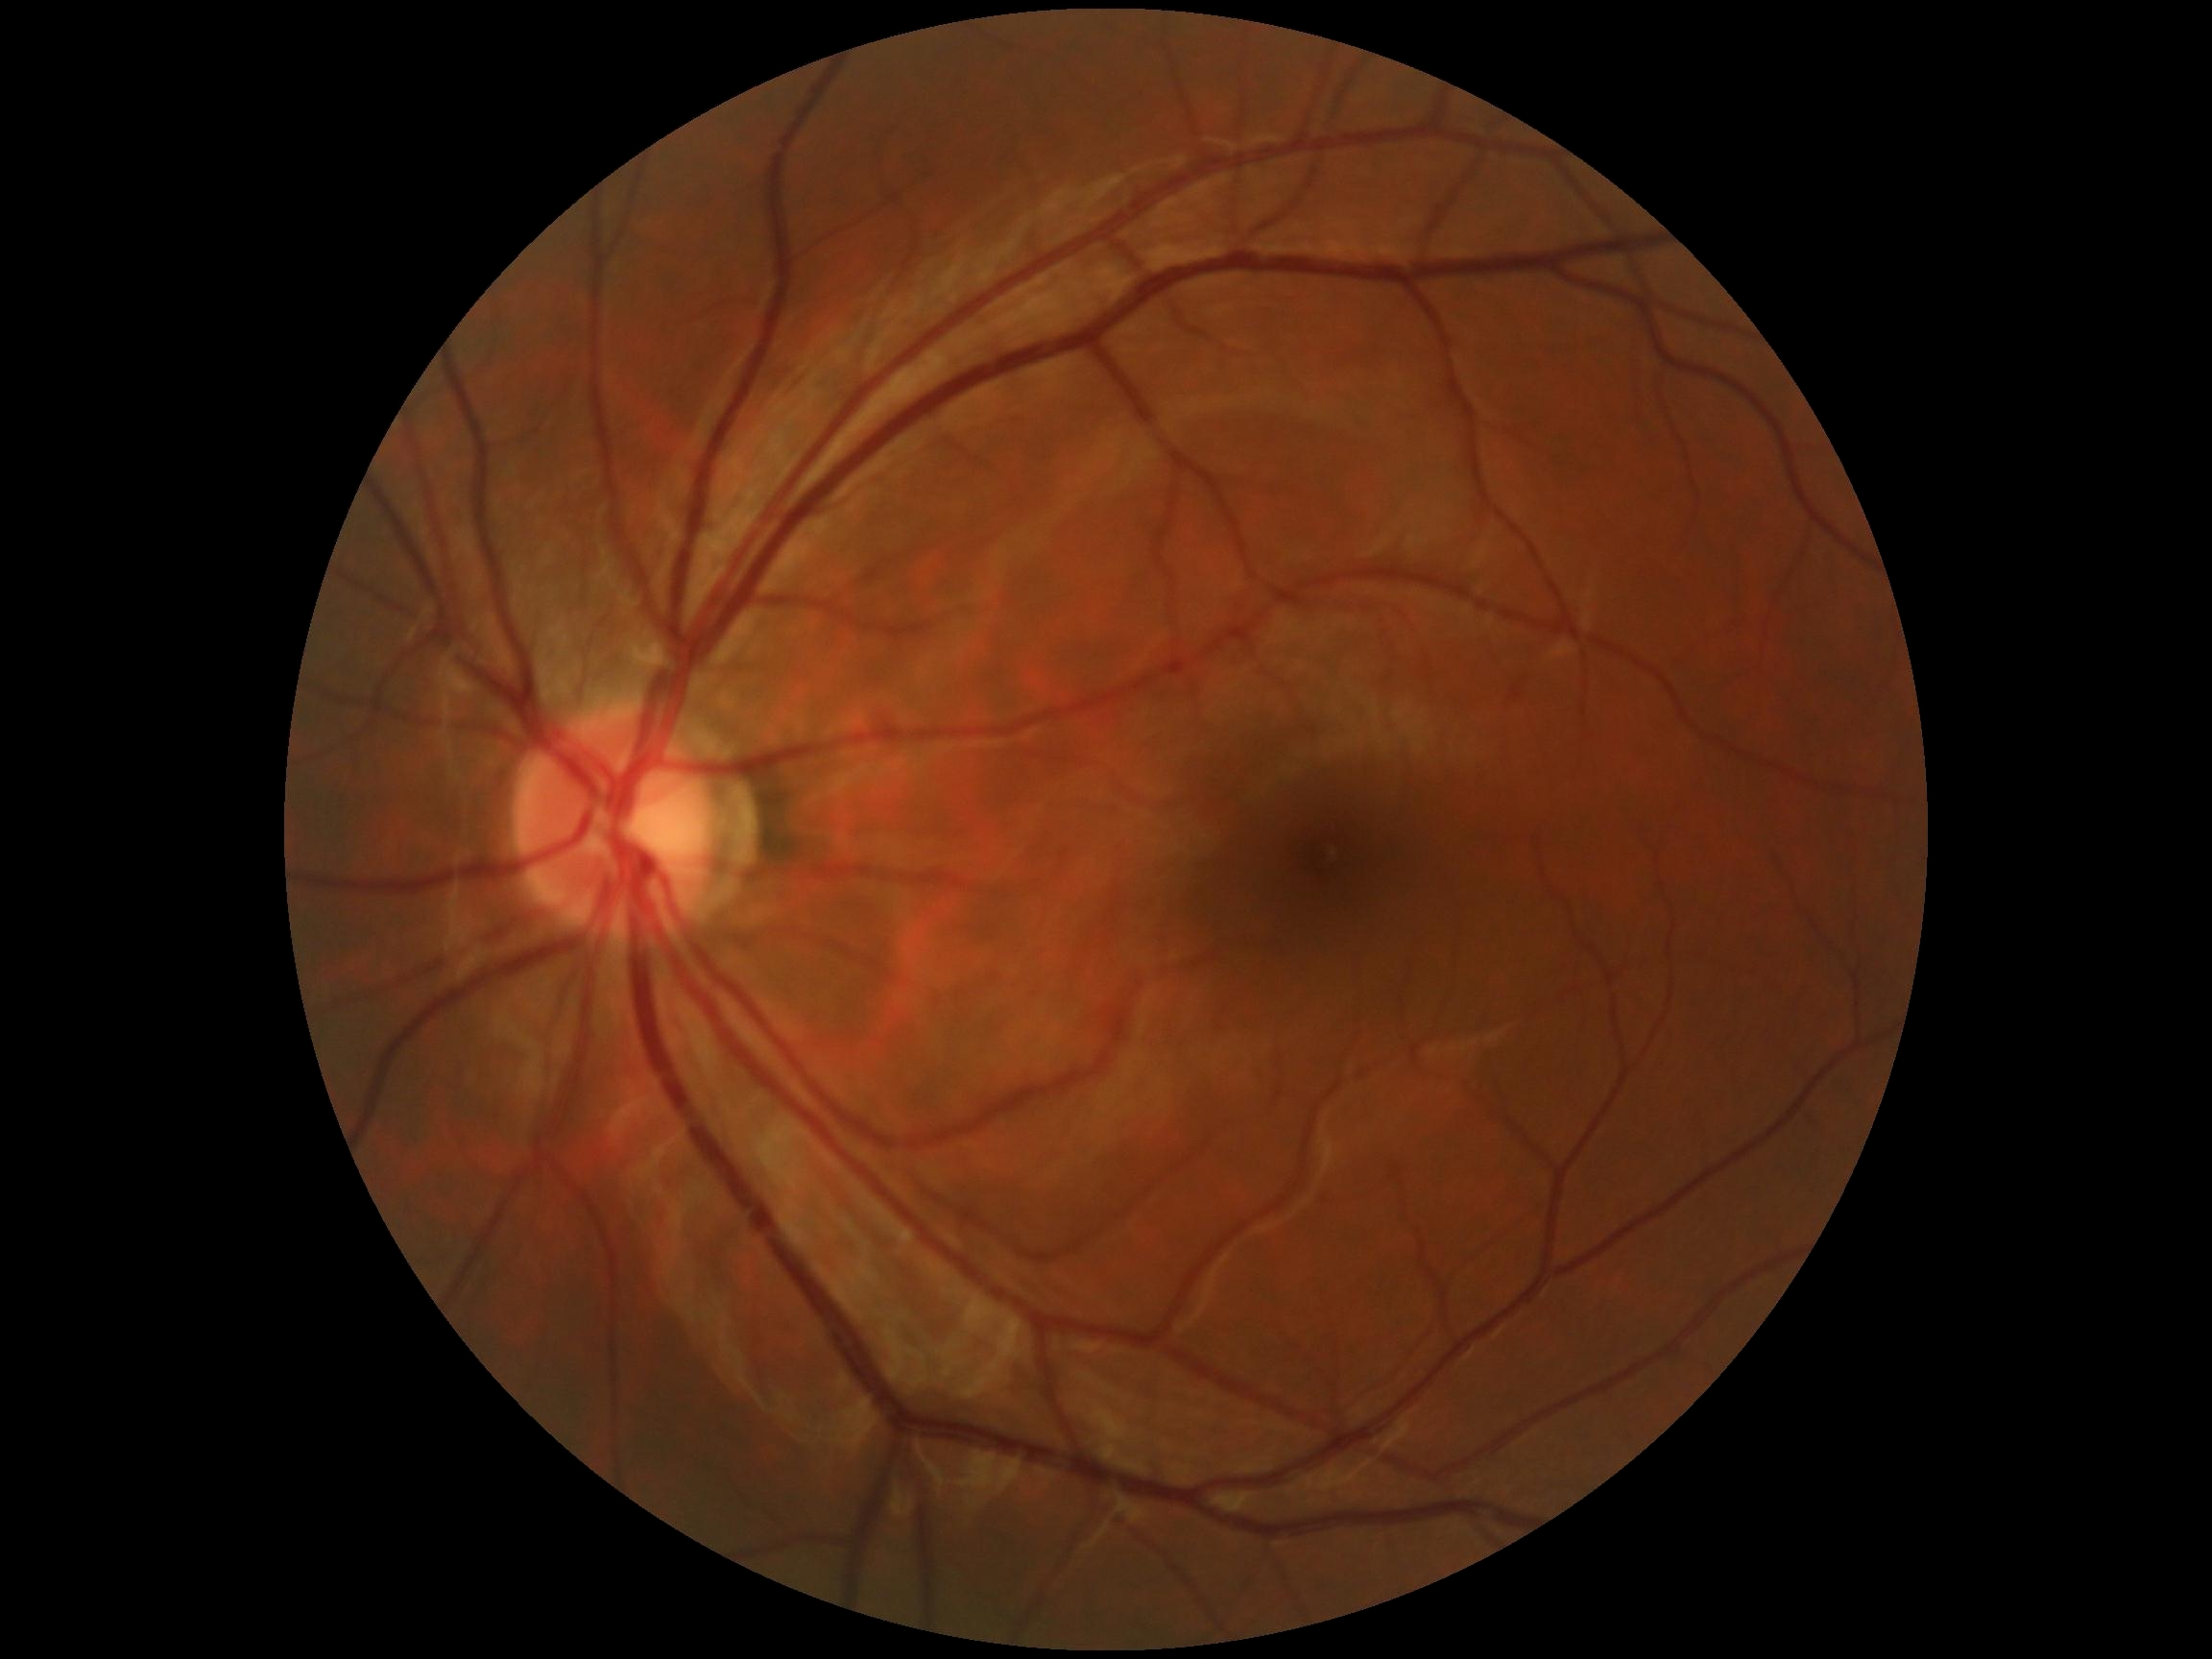 DR: grade 0 (no apparent retinopathy).